Wide-field contact fundus photograph of an infant · 1240 x 1240 pixels · camera: Phoenix ICON (100° FOV) — 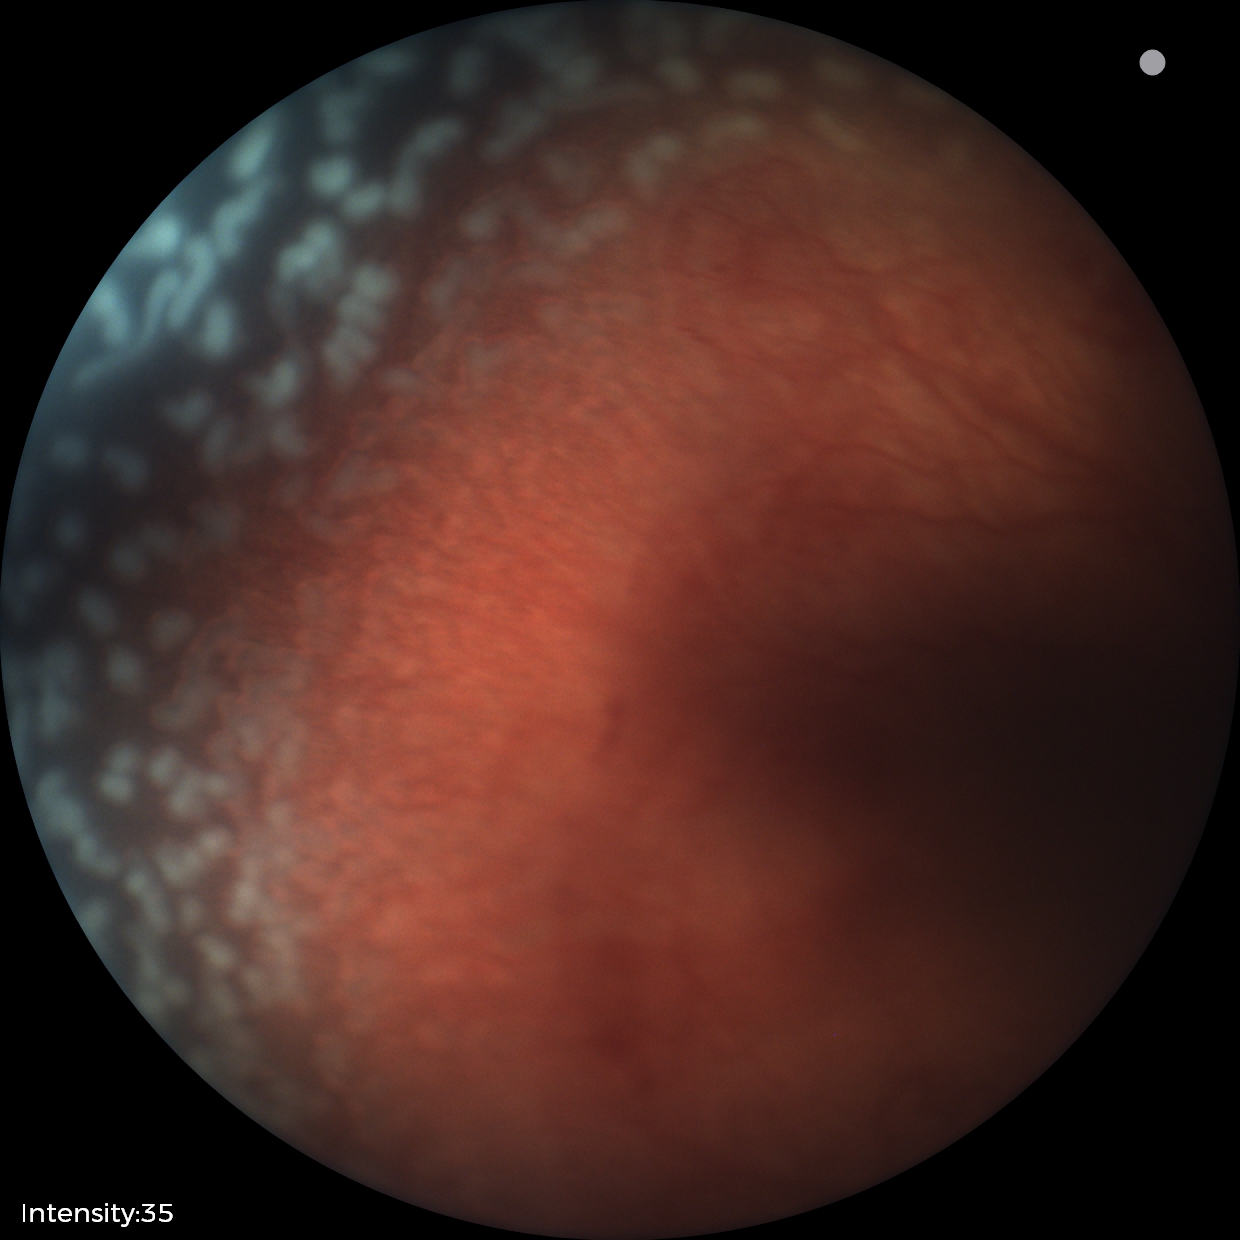
With plus disease.
Screening series with retinopathy of prematurity (ROP) stage 2.